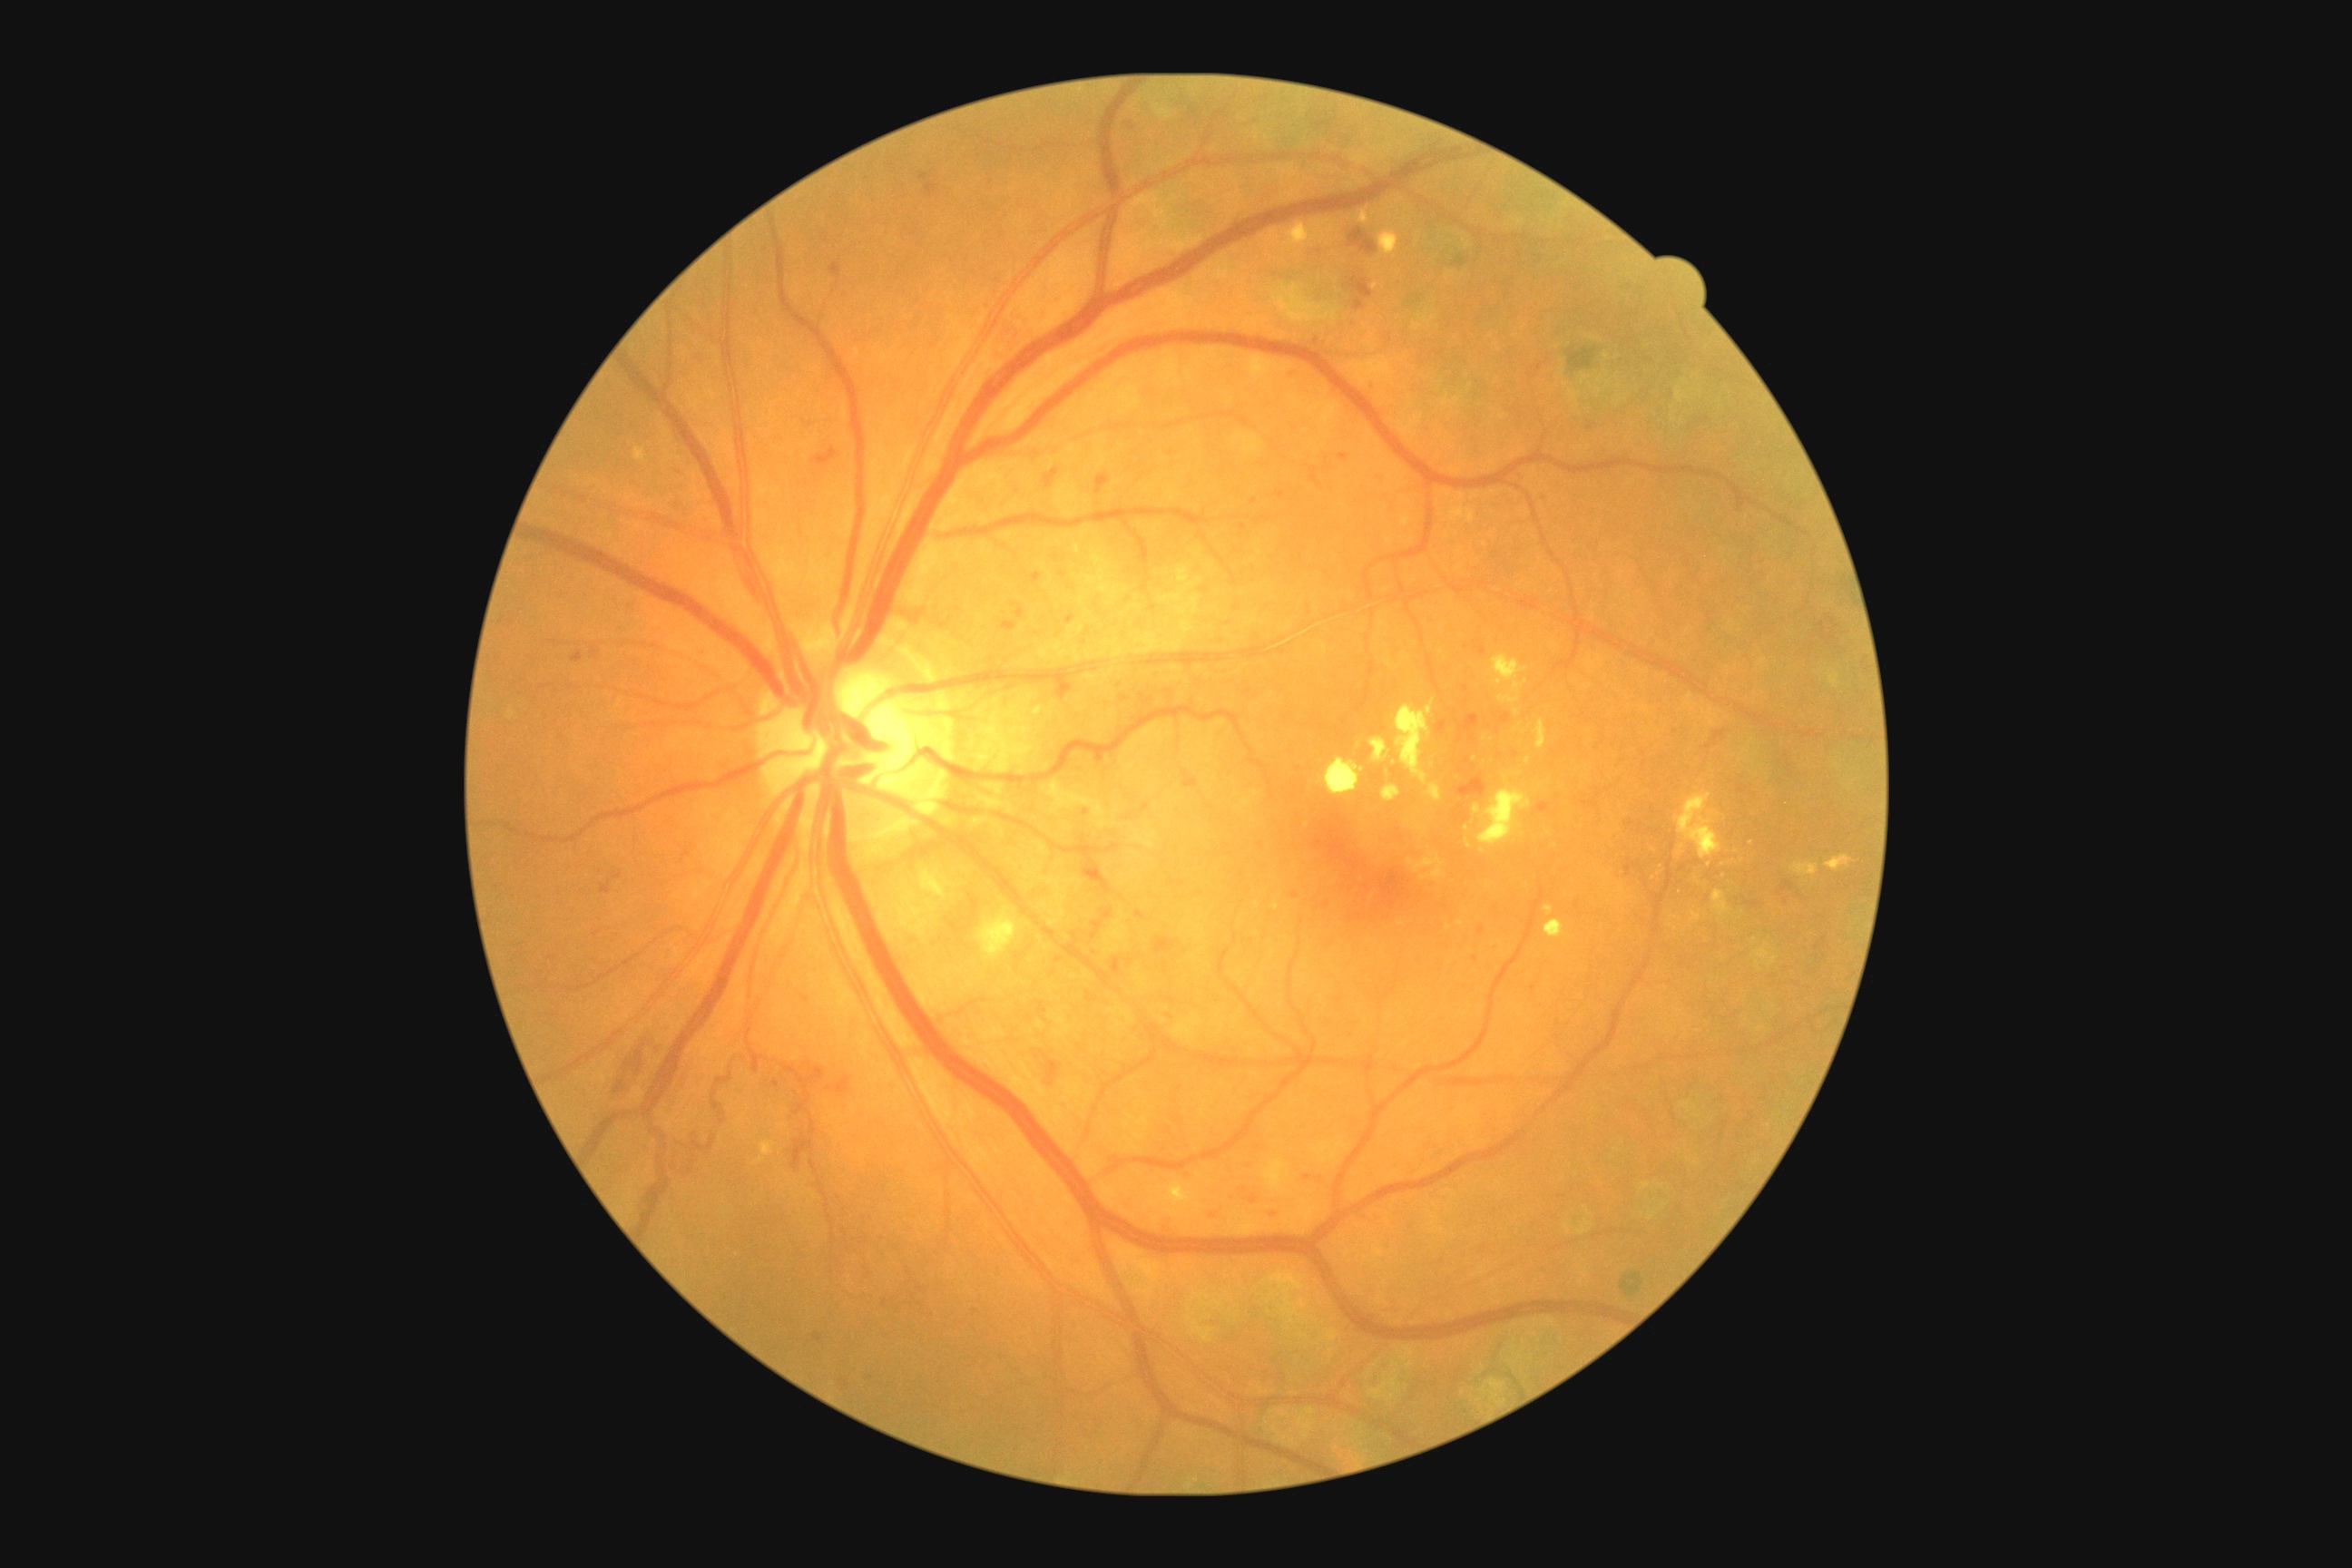

DR grade: 3/4
Lesions identified (partial list):
HEs (subset): Rect(1066, 614, 1073, 625) | Rect(1092, 752, 1104, 767) | Rect(1478, 926, 1485, 936) | Rect(830, 262, 841, 277) | Rect(1705, 729, 1727, 750) | Rect(1625, 863, 1640, 877) | Rect(1090, 948, 1101, 957) | Rect(571, 652, 583, 663) | Rect(1242, 1157, 1260, 1173) | Rect(1458, 807, 1469, 823) | Rect(1373, 475, 1386, 485) | Rect(792, 1139, 814, 1175) | Rect(1157, 1213, 1173, 1235)
Small HEs near 974/1312 | 1316/343 | 1462/772 | 1466/647